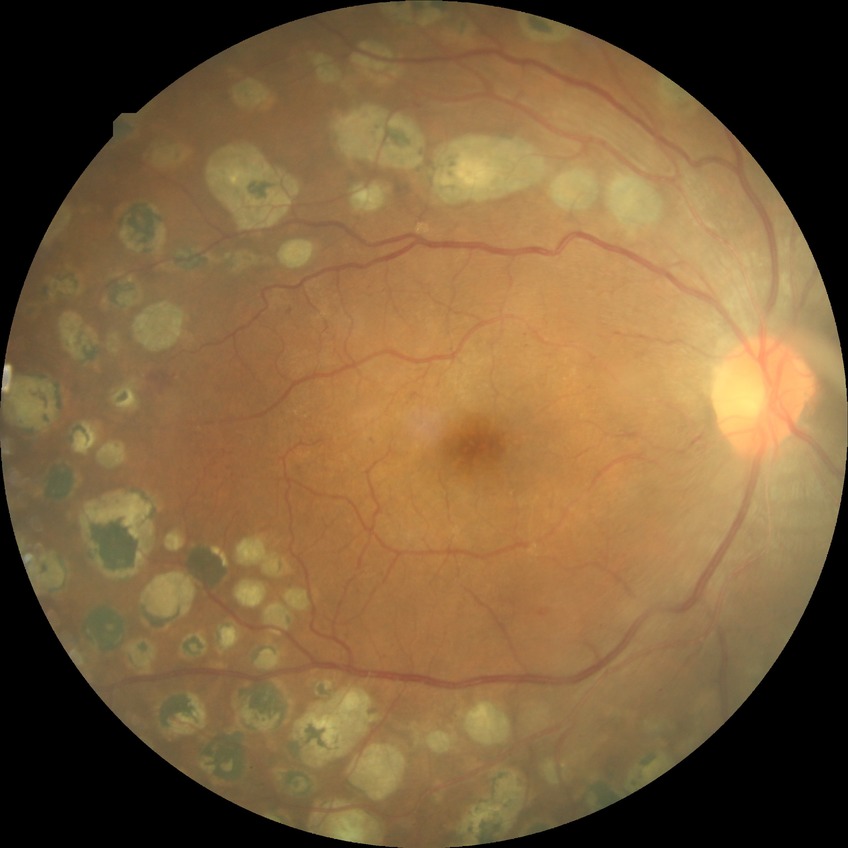
diabetic retinopathy (DR) = PDR (proliferative diabetic retinopathy).